1240 x 1240 pixels · 100° field of view (Phoenix ICON) · wide-field fundus image from infant ROP screening: 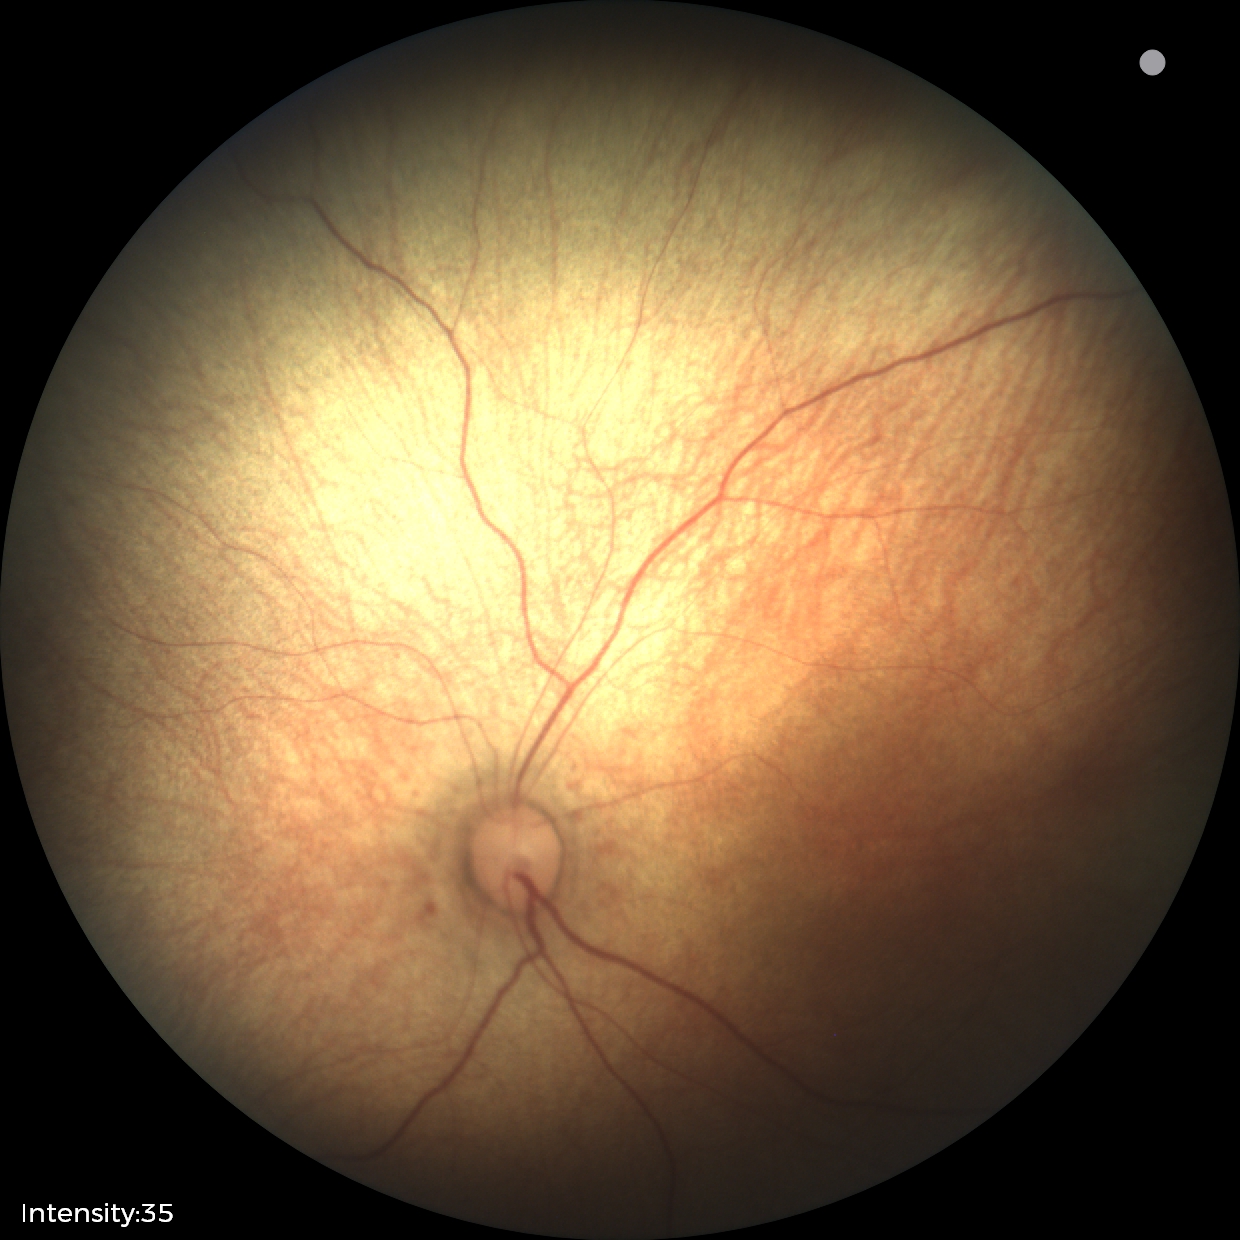
Physiological retinal appearance for postconceptual age.